Optic nerve head photograph — 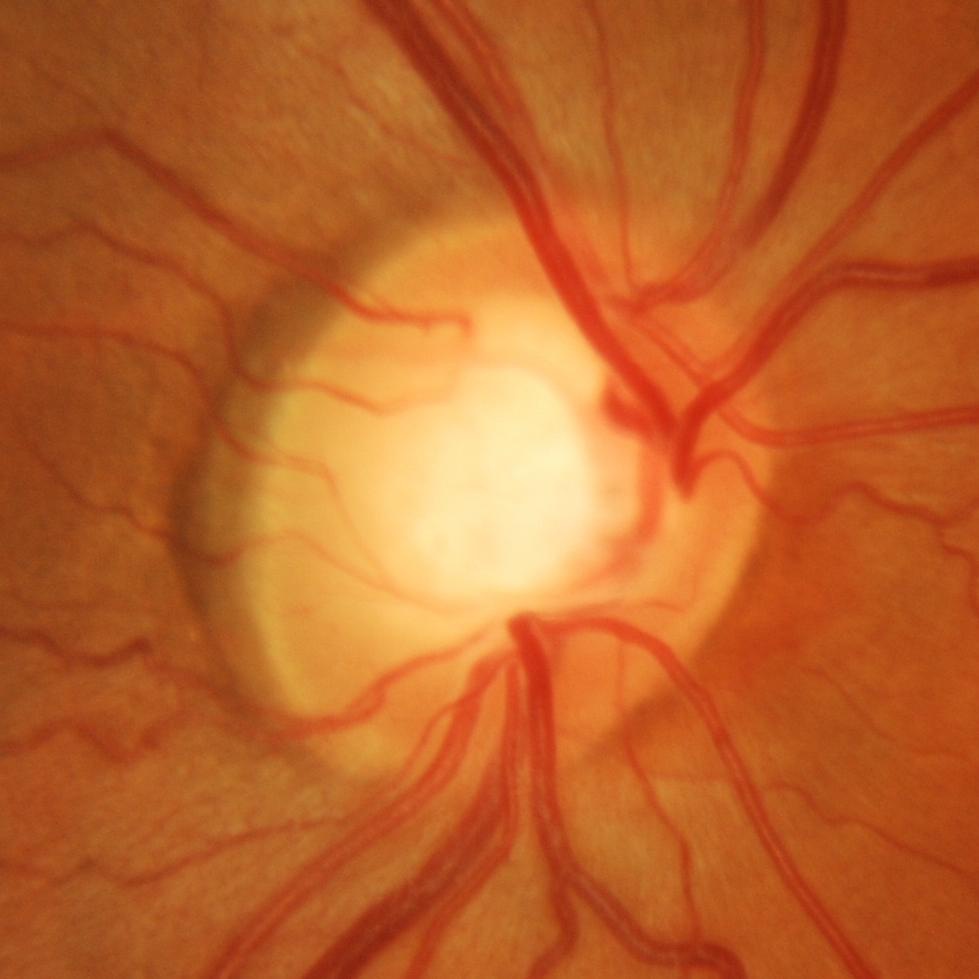 Q: What is the glaucoma diagnosis?
A: Glaucomatous optic neuropathy.